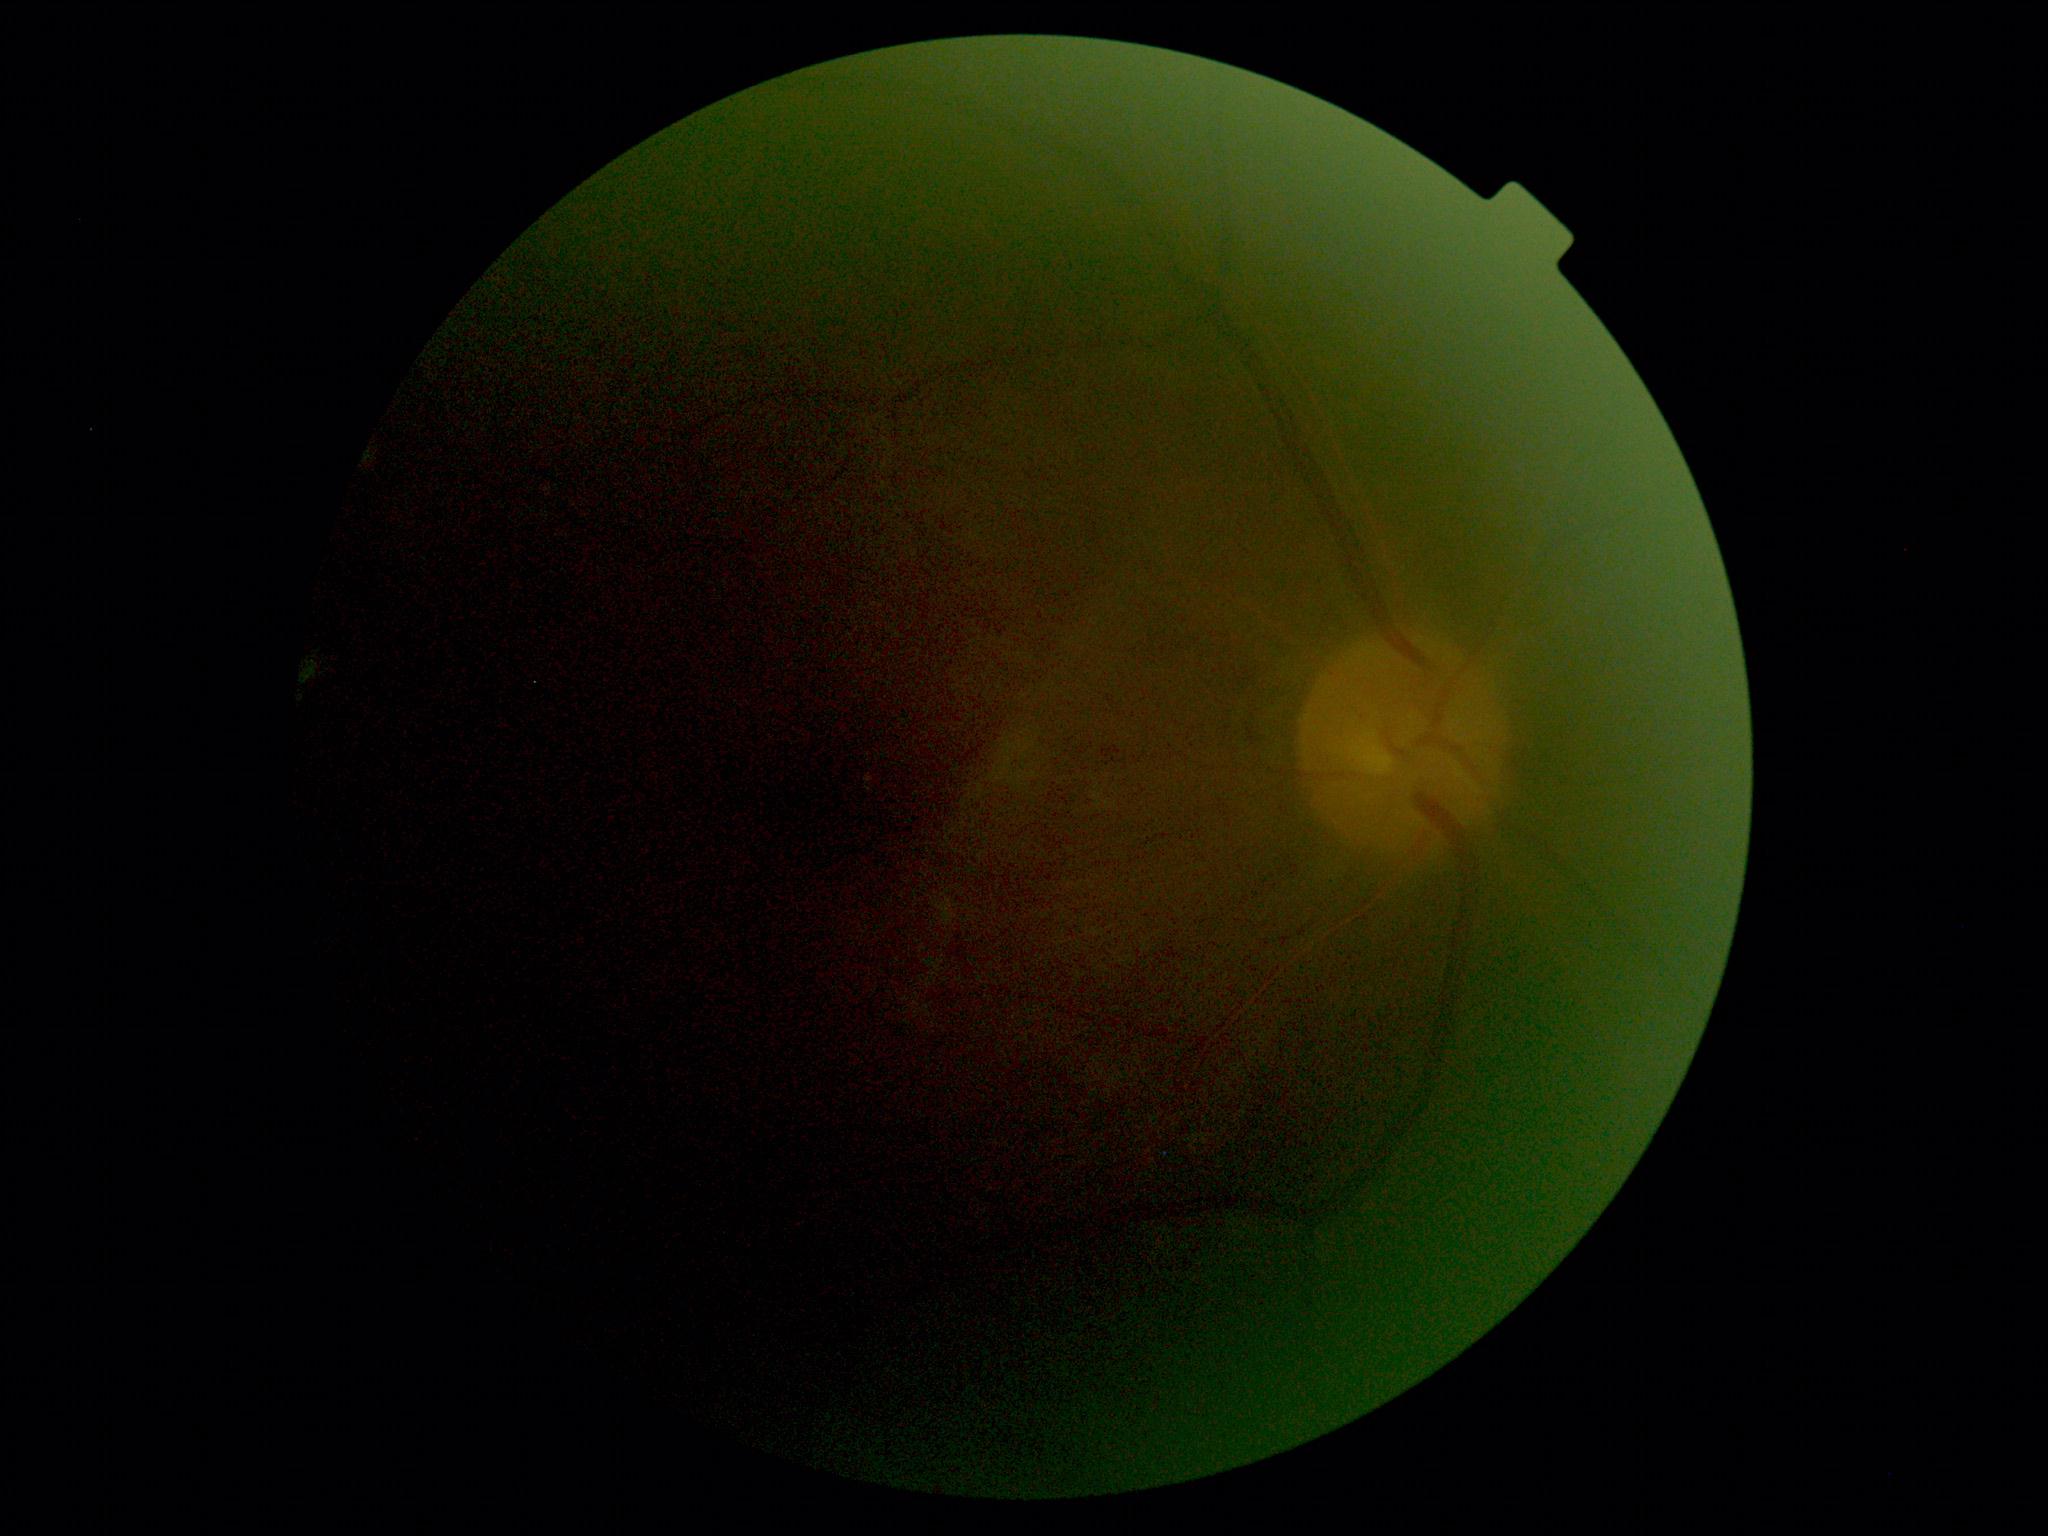 Annotations:
– image quality: insufficient for DR assessment
– diabetic retinopathy severity: ungradable due to poor image quality